Color fundus image, 45° field of view, 2352x1568:
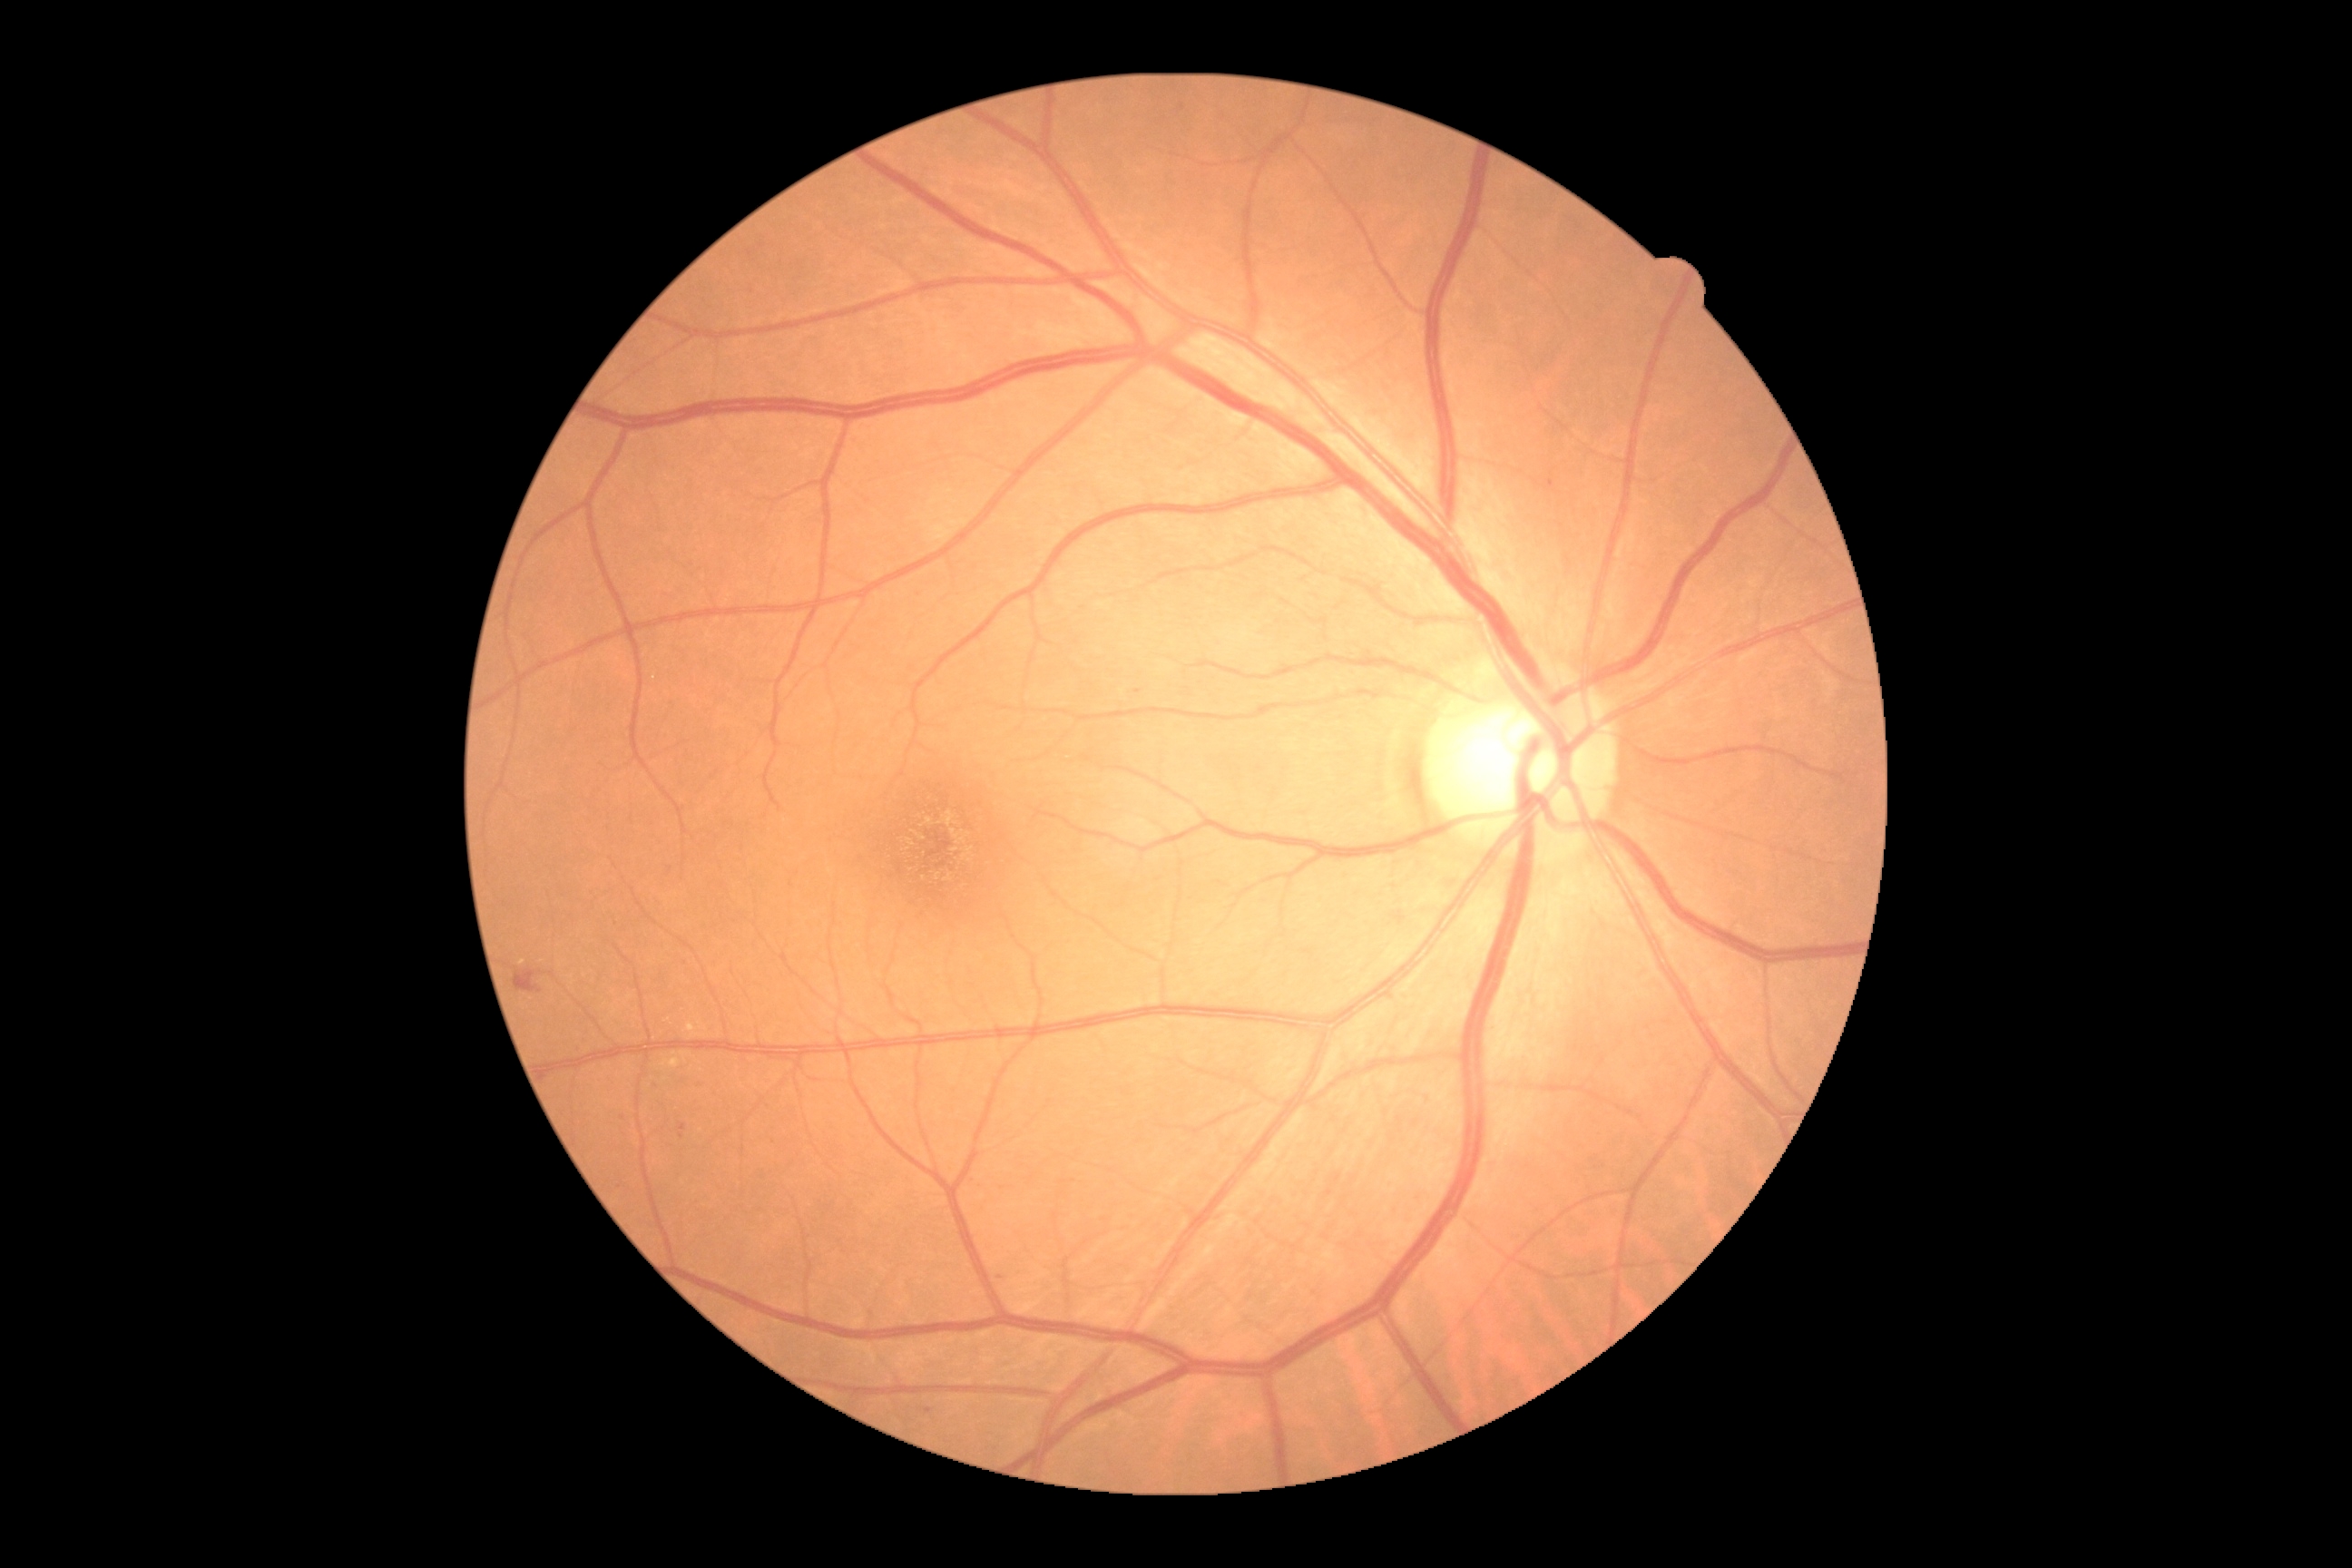
Findings:
- DR stage — grade 2 (moderate NPDR)